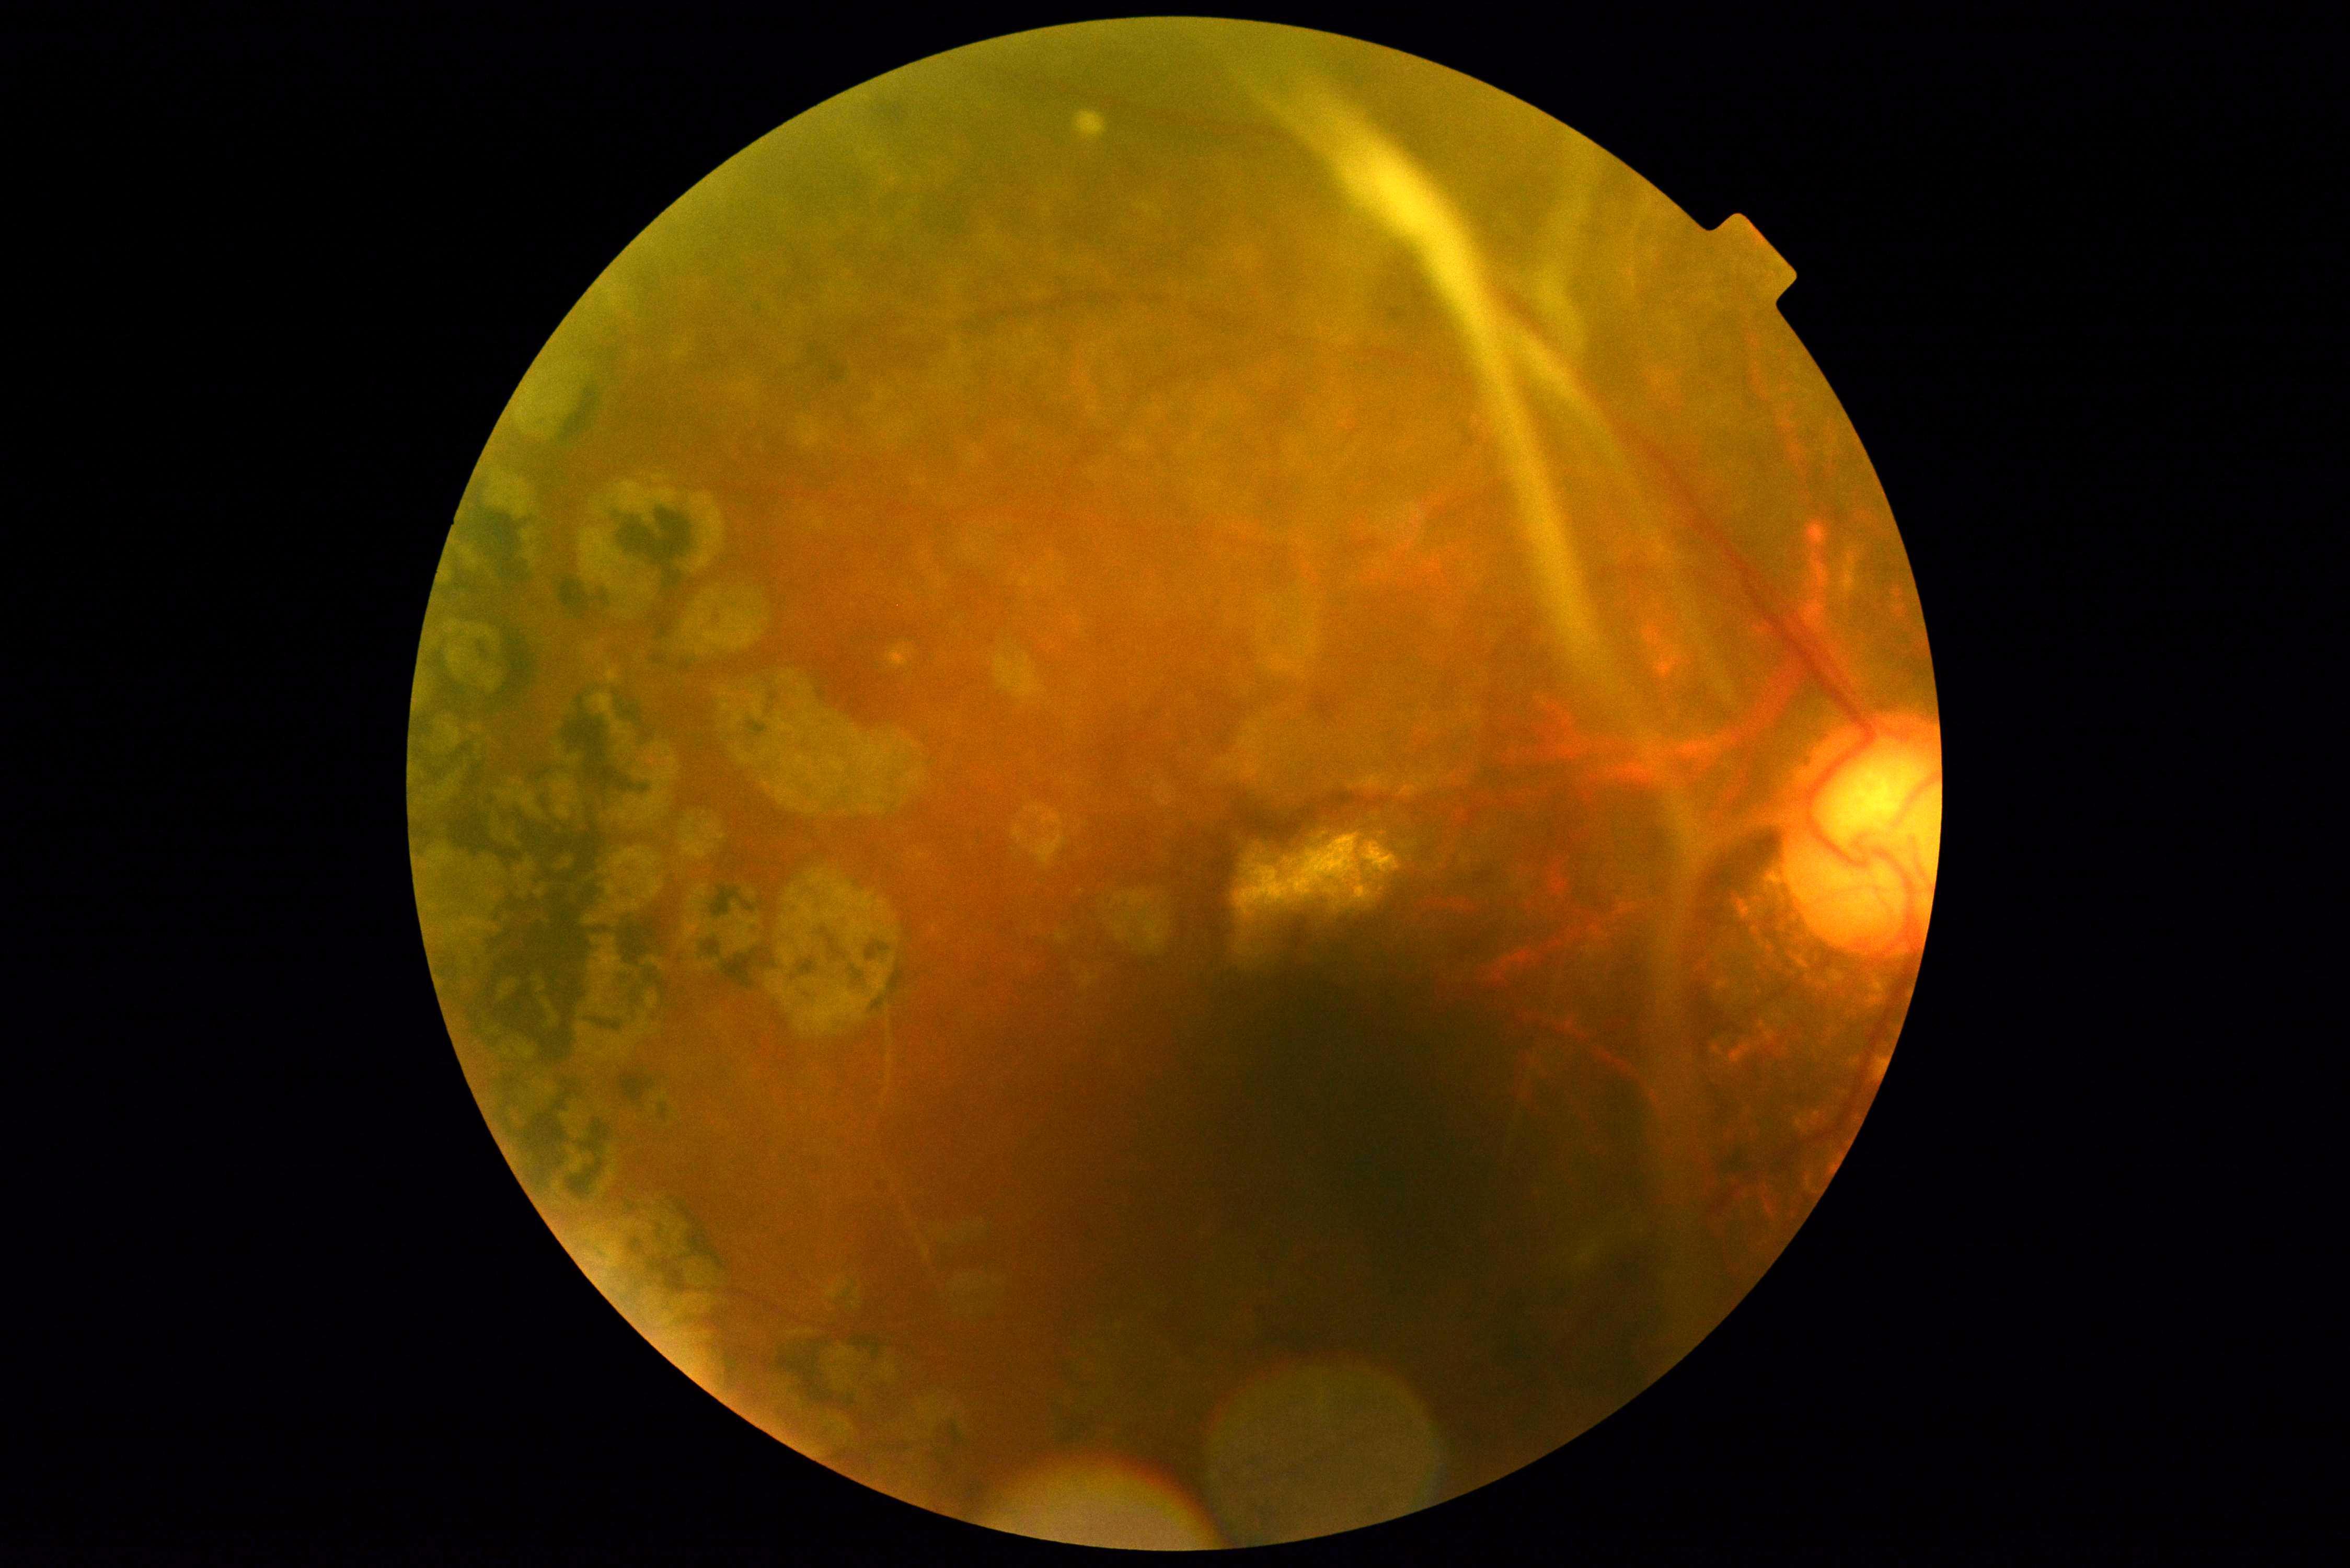
Diabetic retinopathy is 4 — neovascularization and/or vitreous/pre-retinal hemorrhage.